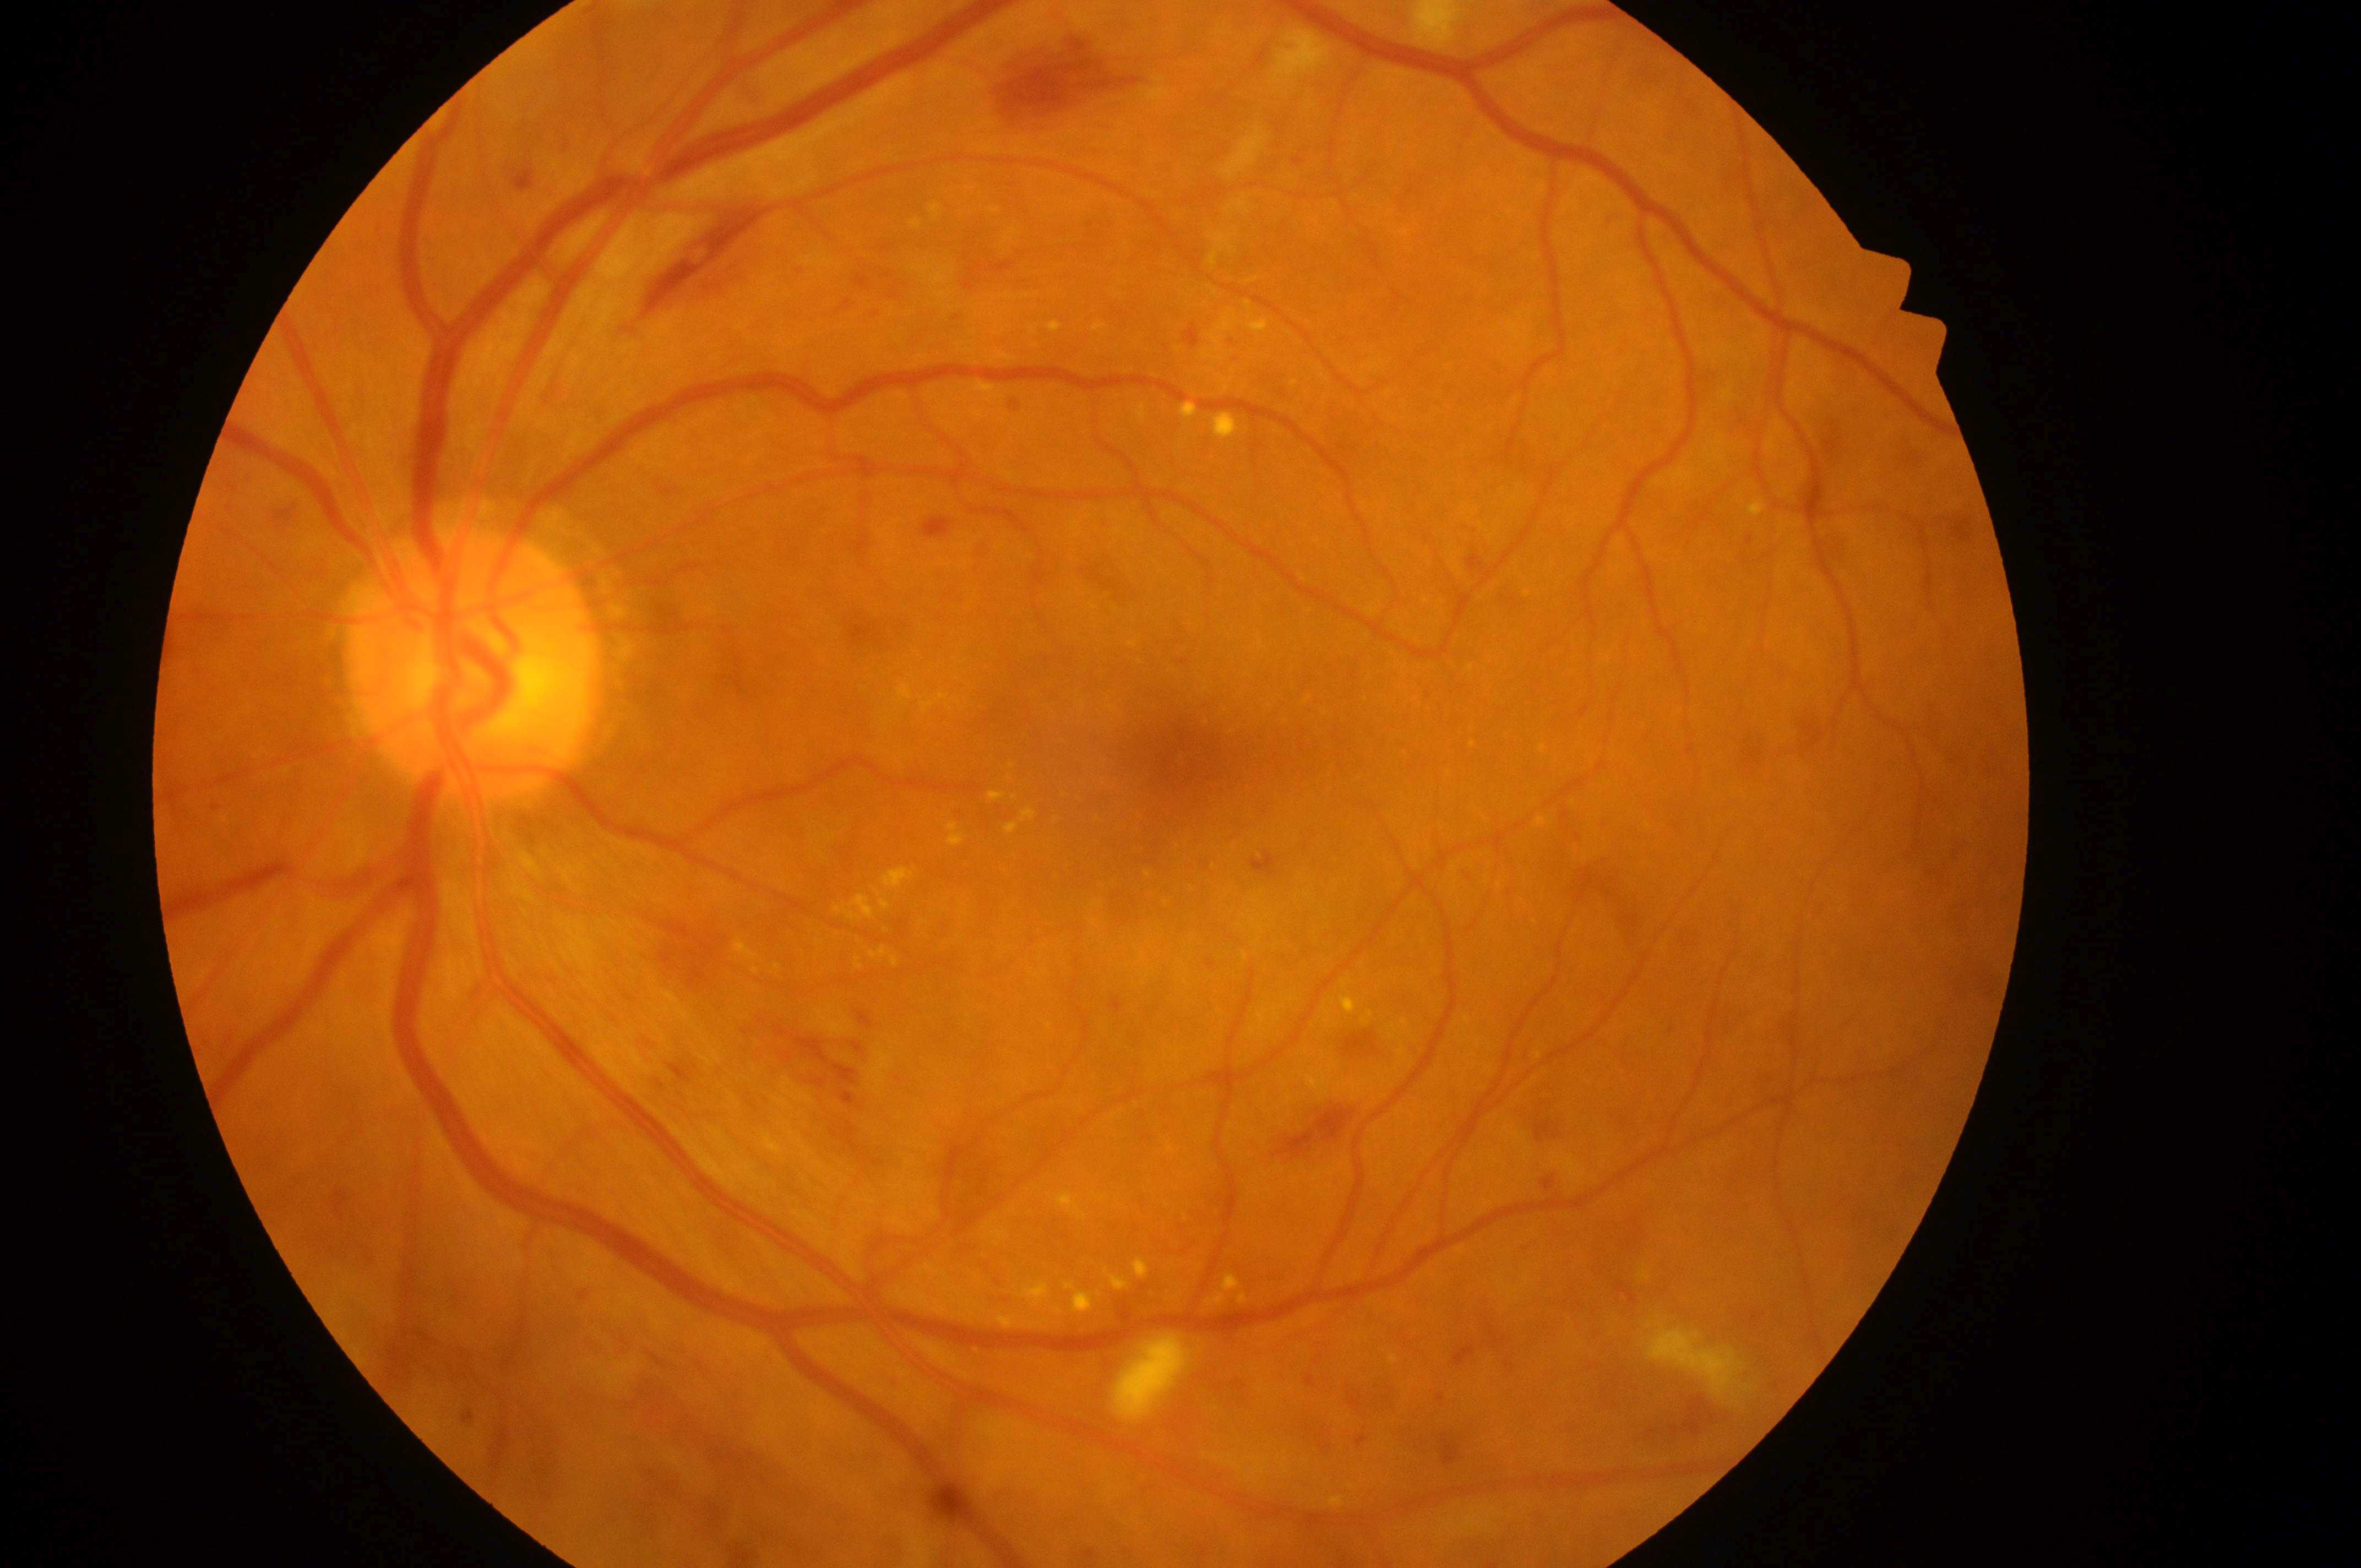 DME risk: 2/2.
The image shows the left eye.
DR stage: grade 3.
The retinopathy is classified as non-proliferative diabetic retinopathy.
The macula center is at 1184px, 765px.
The disc center is at 468px, 674px.